Davis DR grading. 848 x 848 pixels
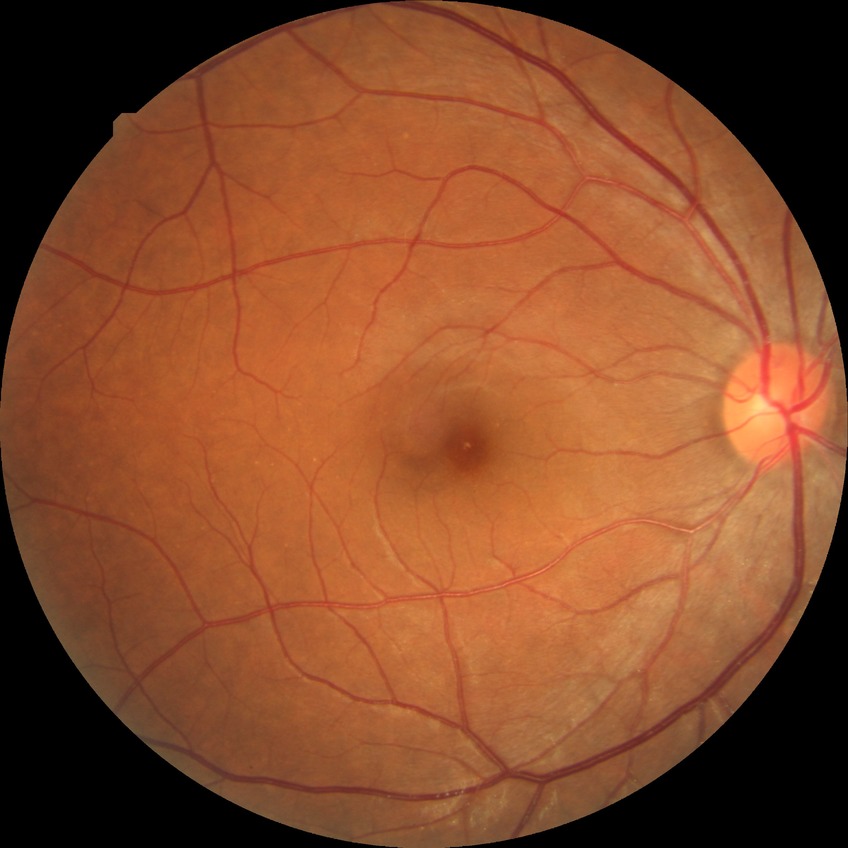
modified Davis grade = NDR; DR impression = no signs of DR.